Retinal fundus photograph · 848x848 · camera: NIDEK AFC-230 · modified Davis classification · 45-degree field of view · nonmydriatic — 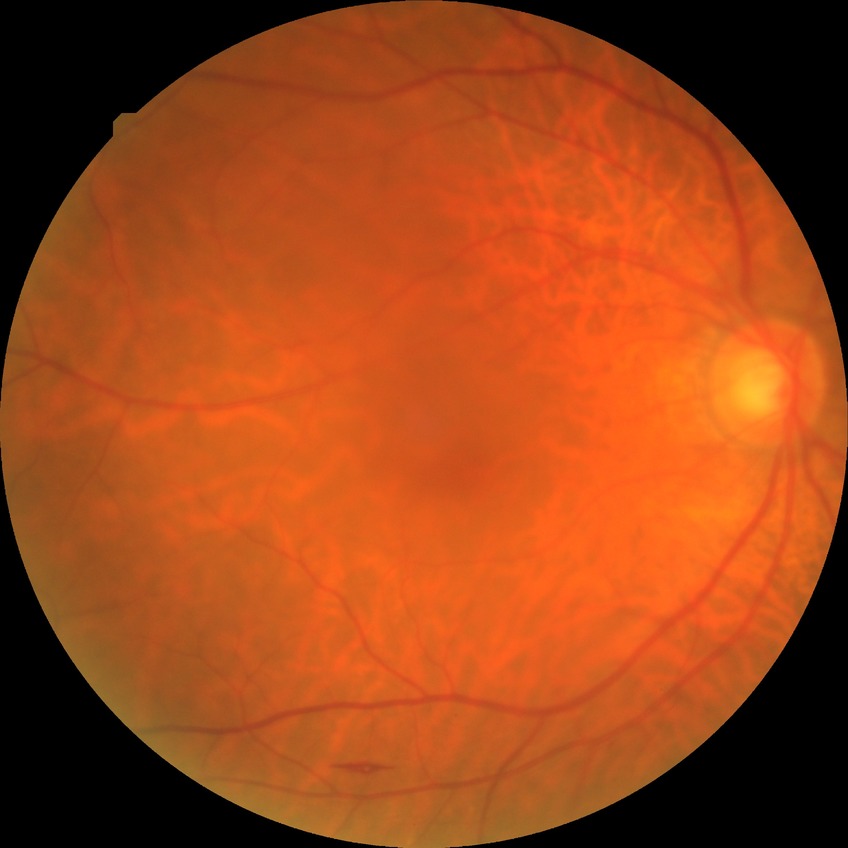 Davis DR grade: SDR.